Infant wide-field retinal image:
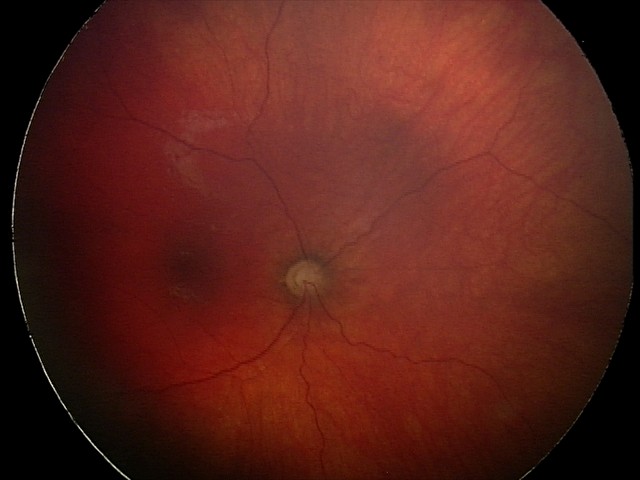

From an examination with diagnosis of optic nerve hypoplasia.